Retinal fundus photograph; 1624x1232px
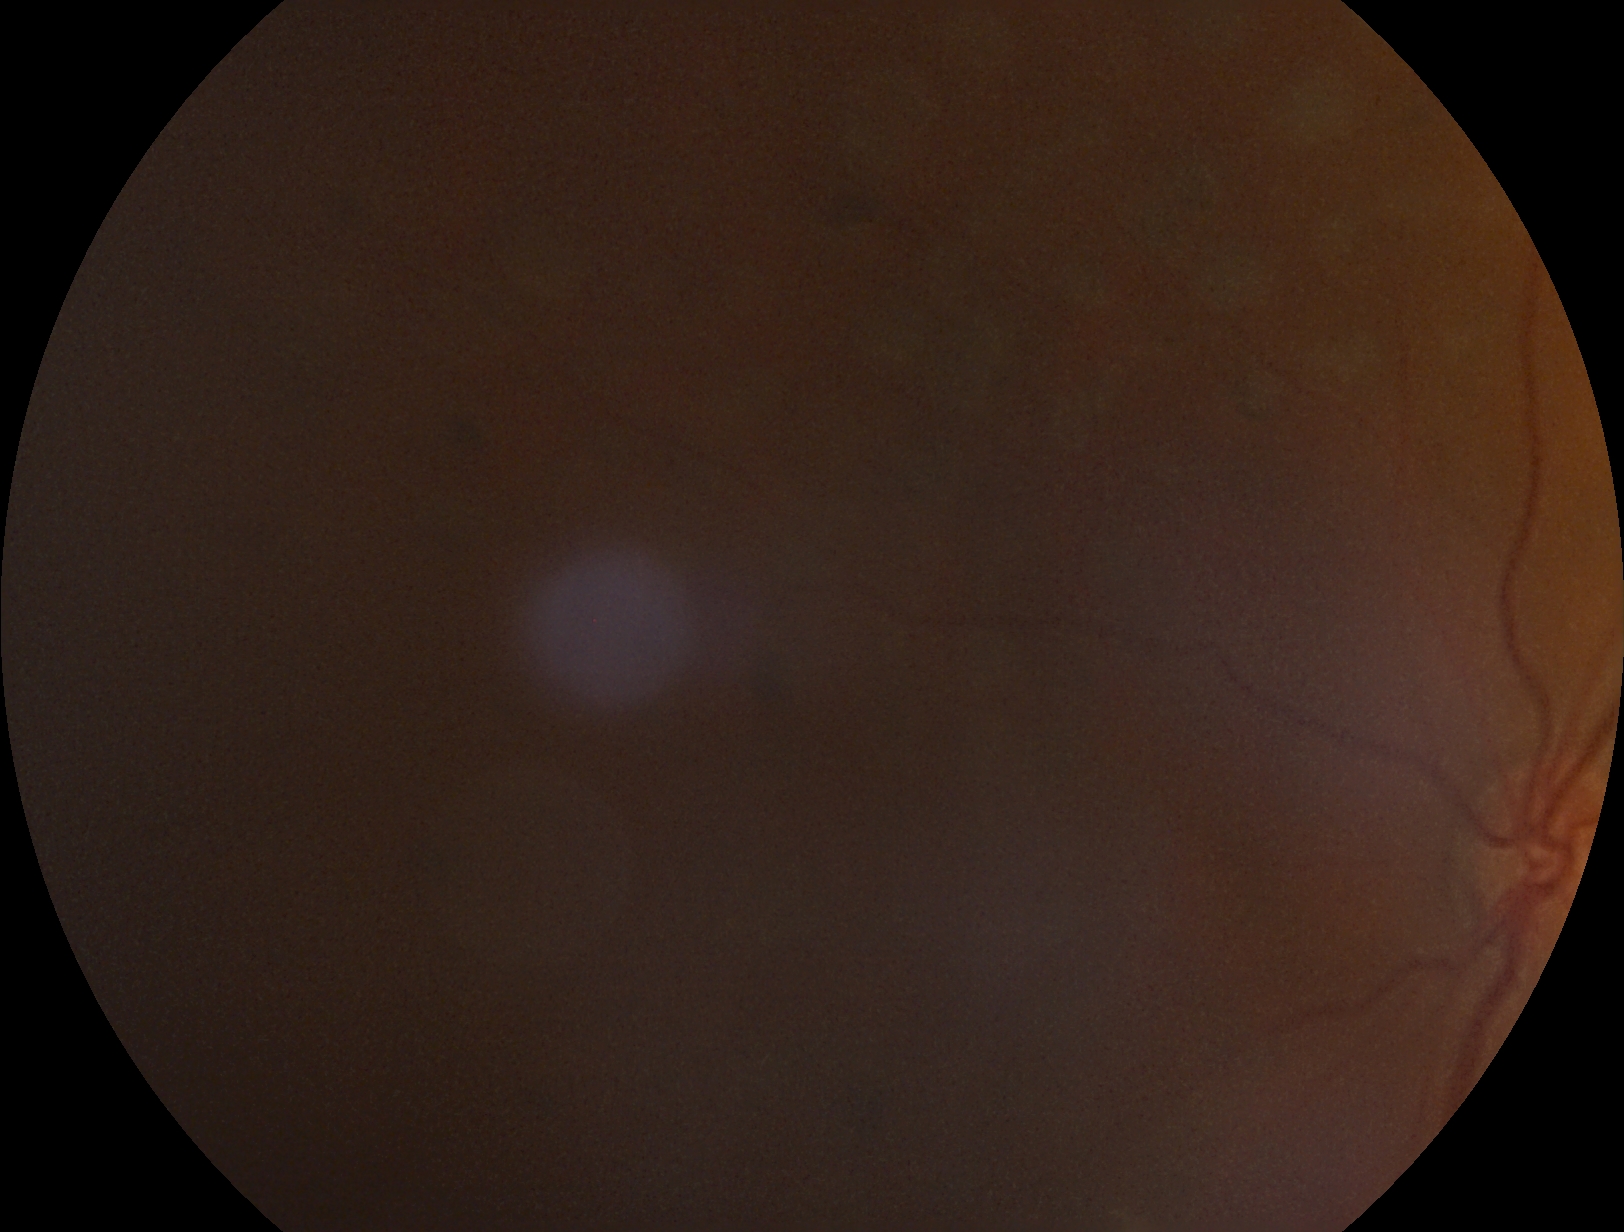 {"dr_grade": "ungradable due to poor image quality", "quality": "below grading threshold"}